Modified Davis classification
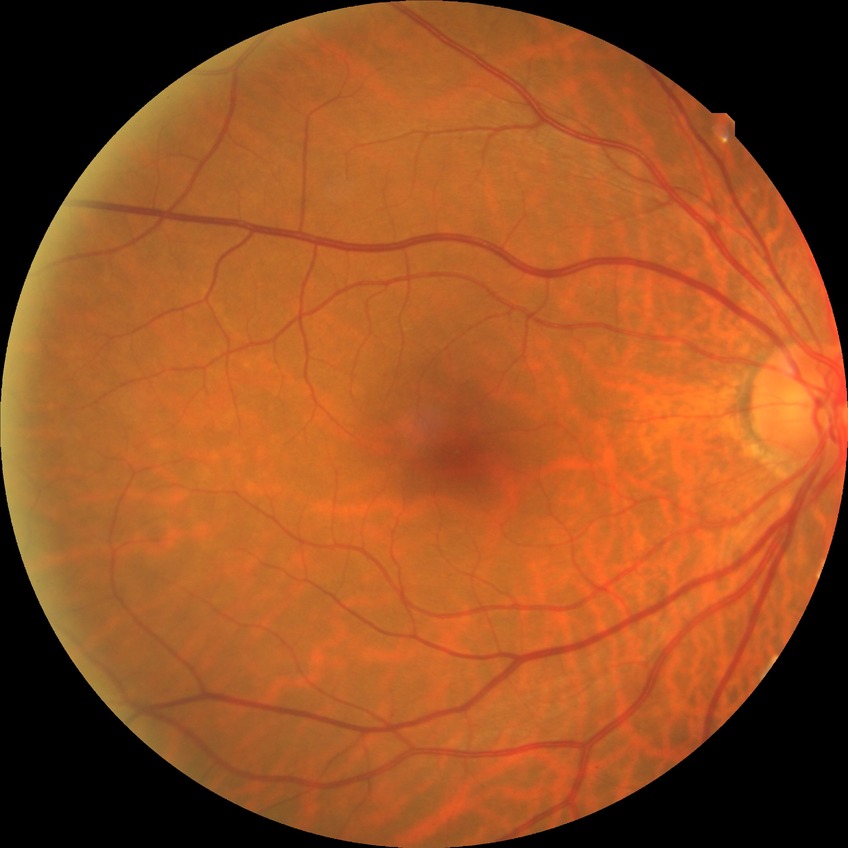

Diabetic retinopathy (DR) is NDR (no diabetic retinopathy).